Fundus photo, 412x310px: 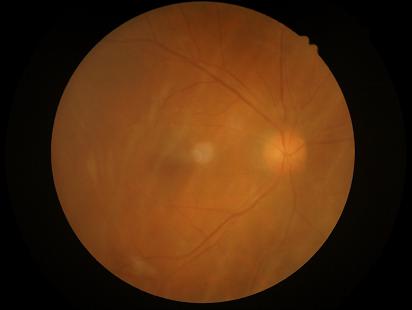 {
  "clarity": "noticeable blur in the optic disc, vessels, or background",
  "contrast": "wide intensity range, structures distinguishable",
  "illumination": "uniform, no color cast",
  "overall_quality": "poor, ungradable"
}